45° FOV:
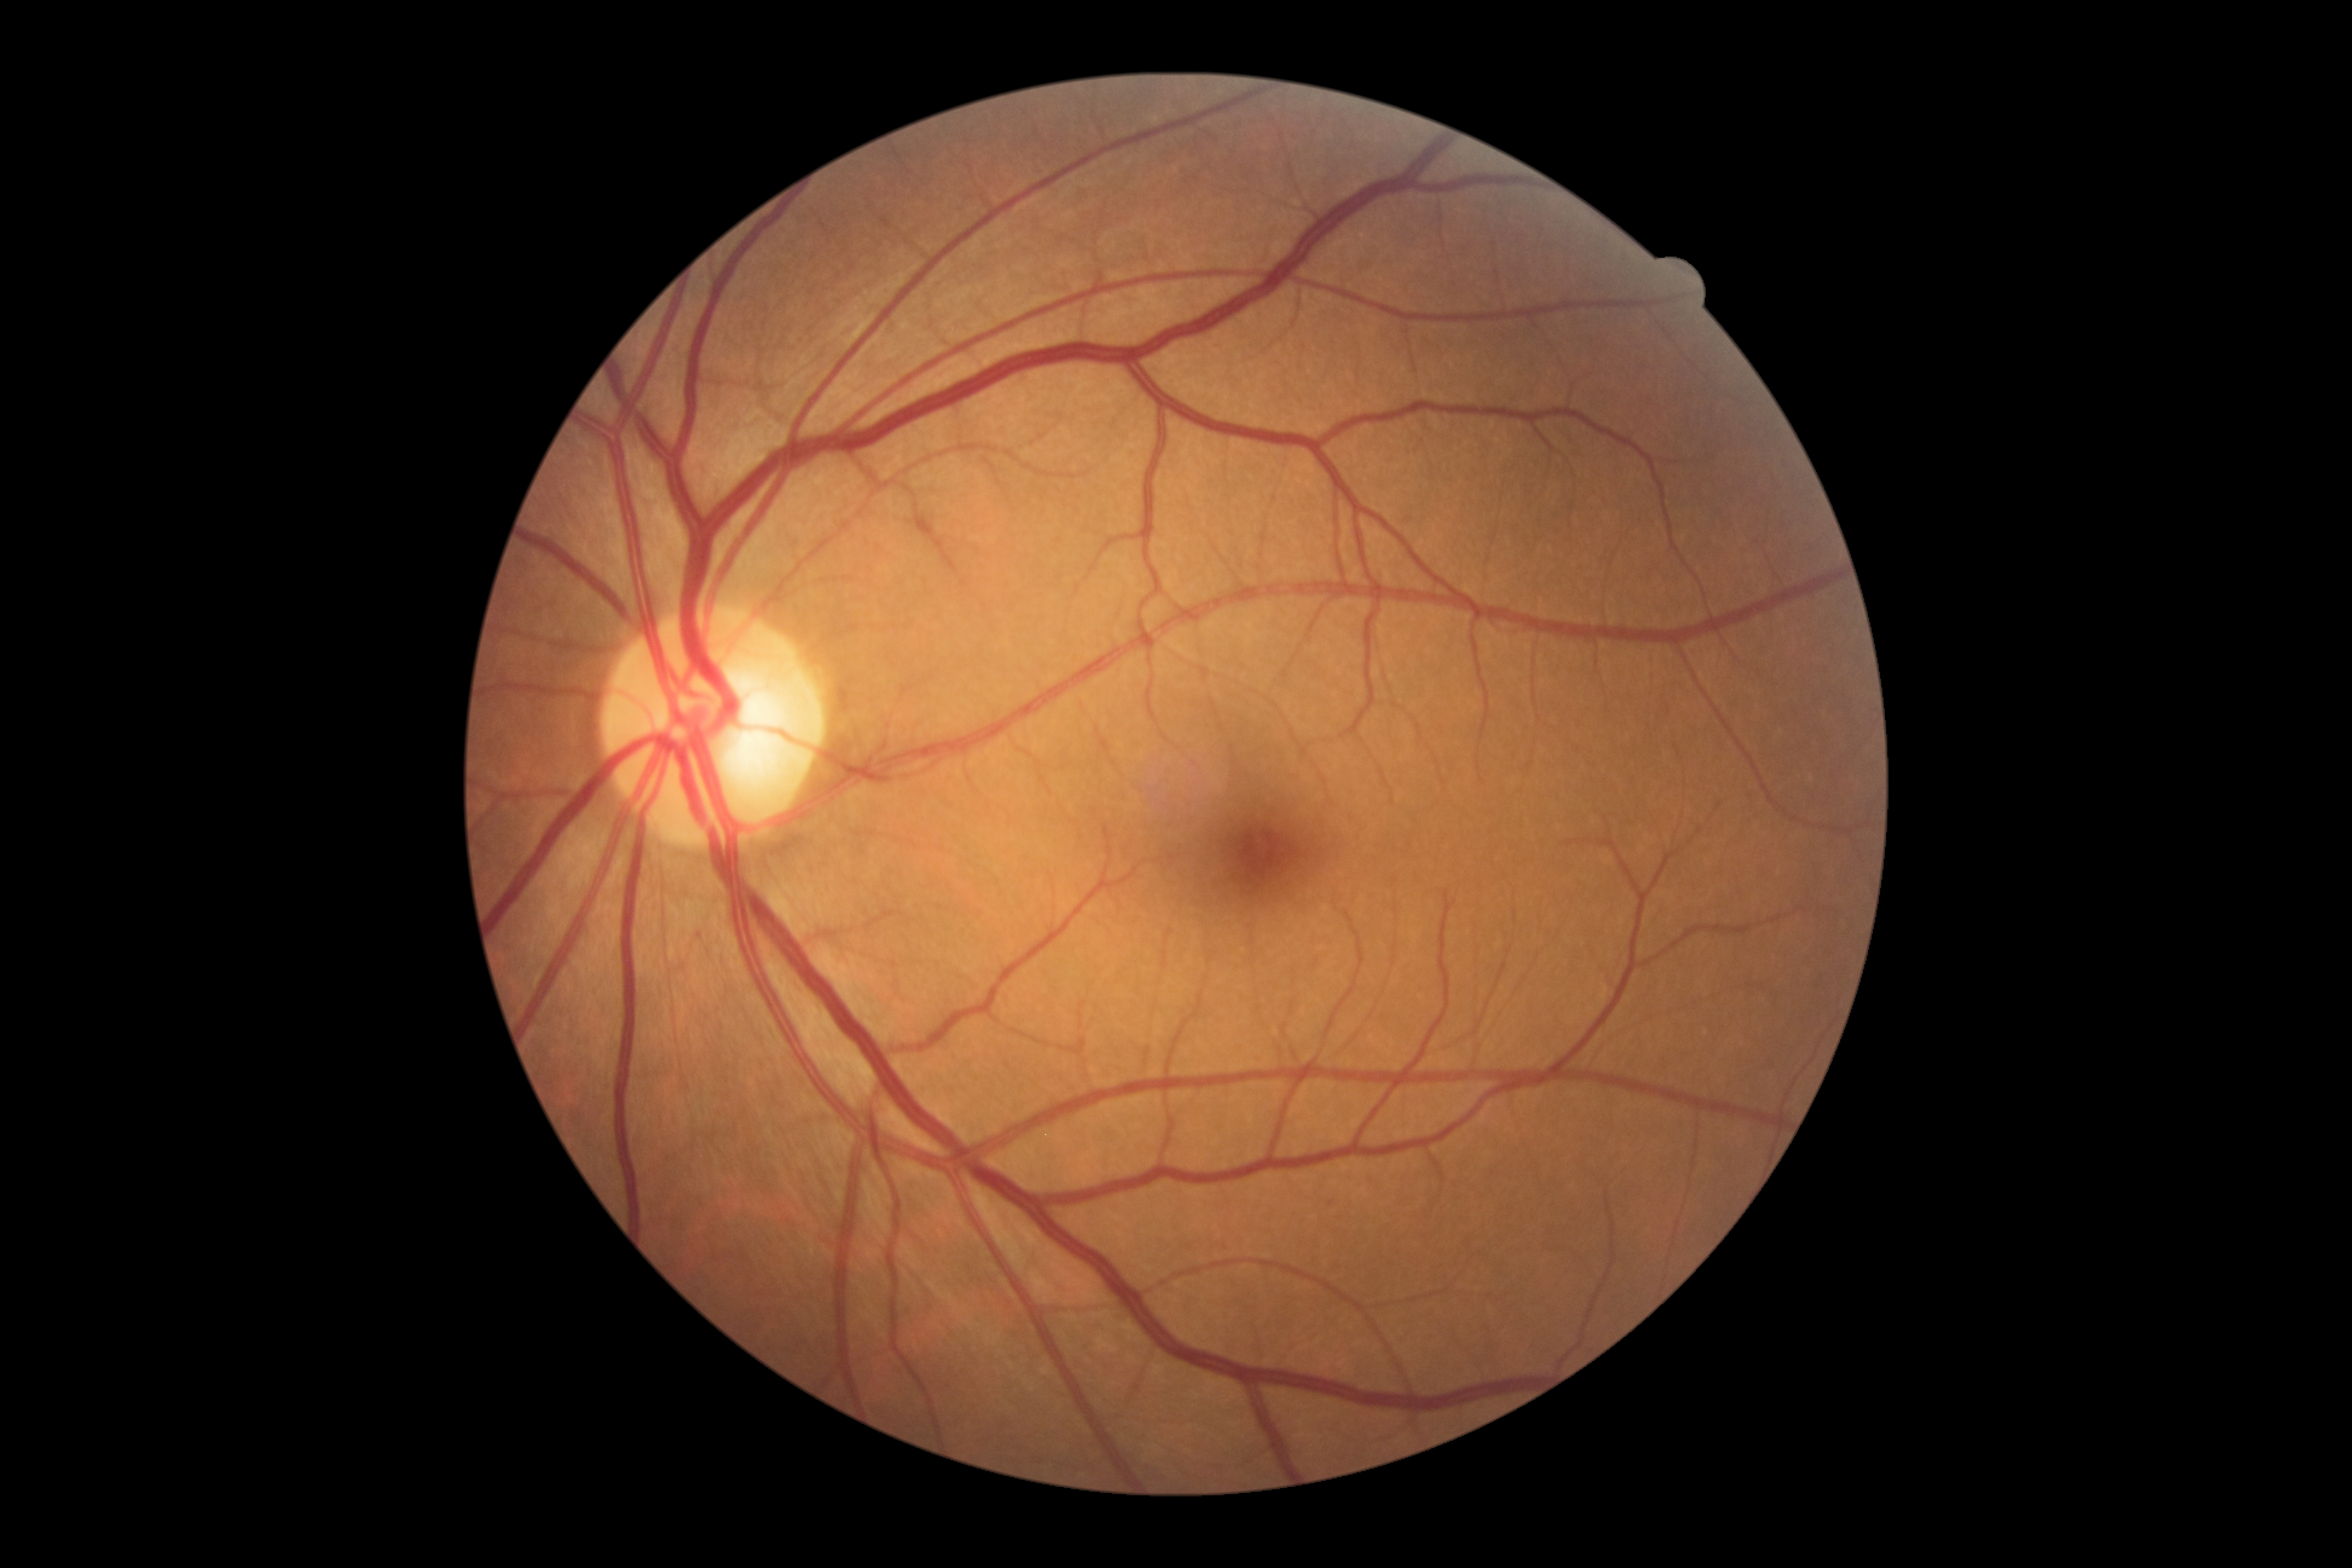

DR is grade 0 (no apparent retinopathy). No diabetic retinal disease findings.